Image size 1380x1382. Color fundus photograph: 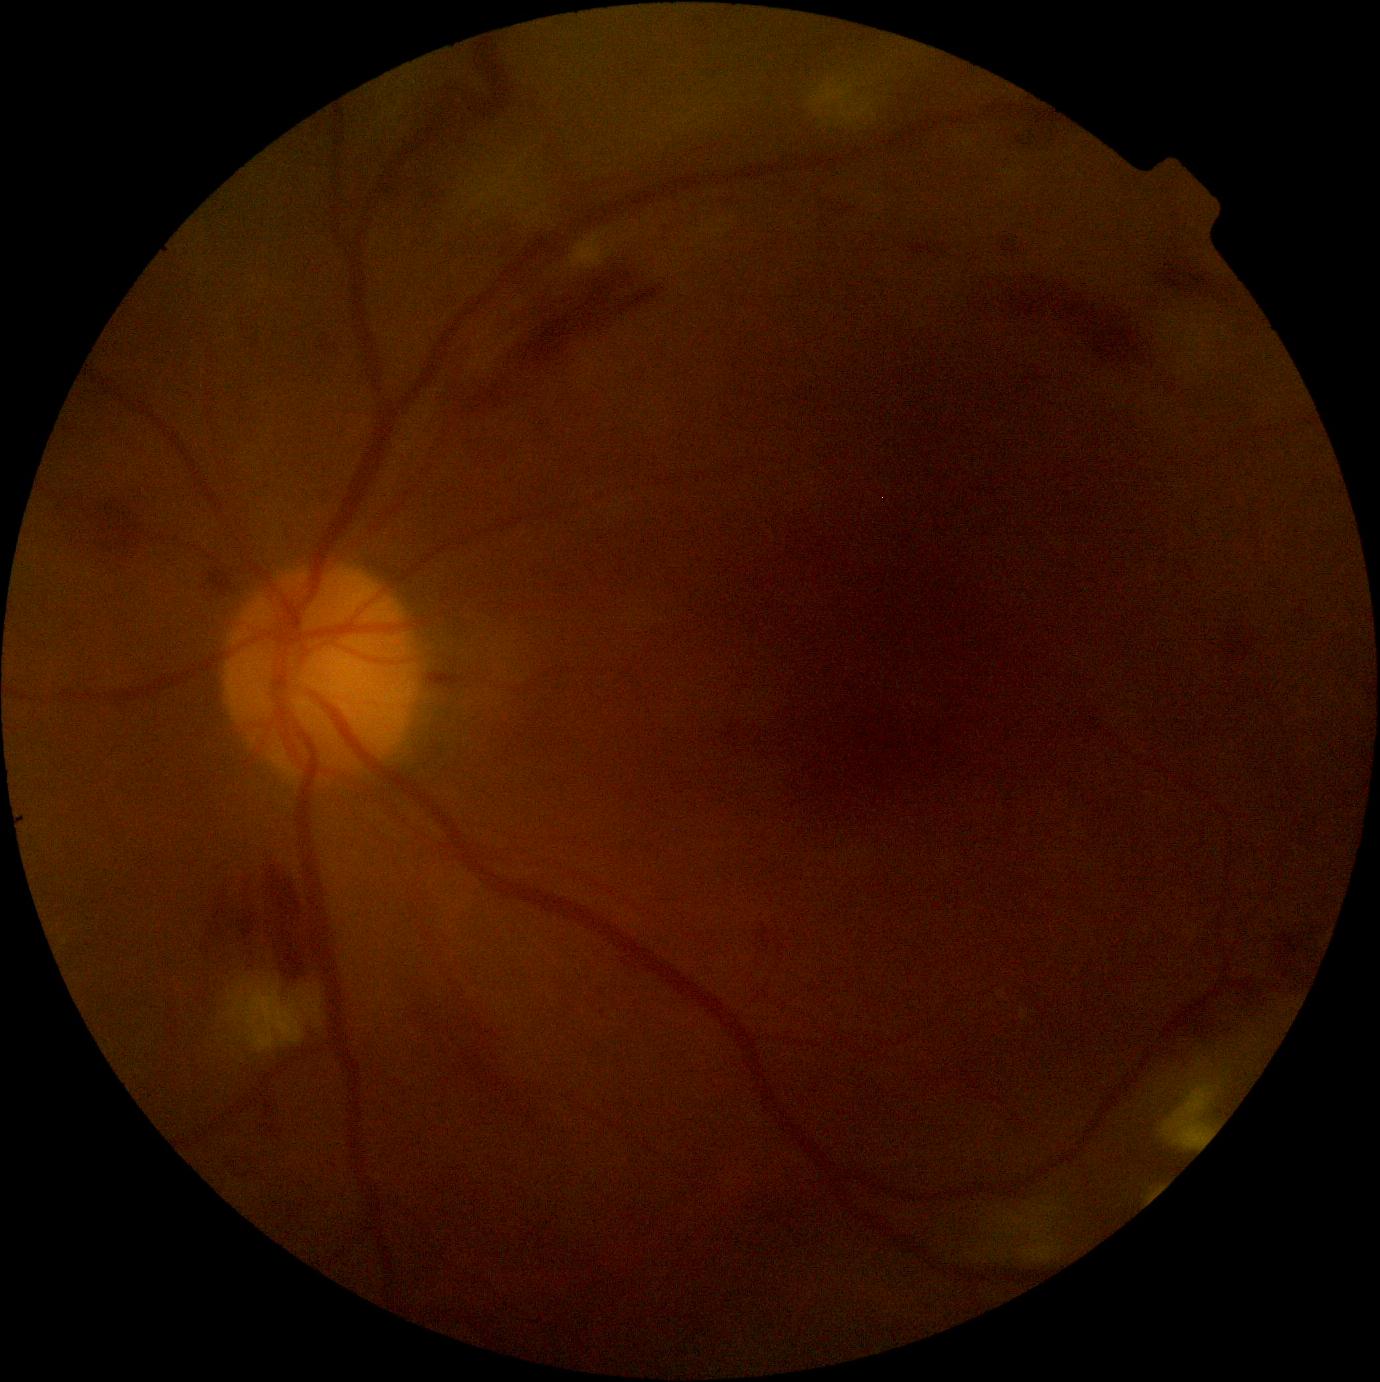

DR = moderate non-proliferative diabetic retinopathy (grade 2) — more than just microaneurysms but less than severe NPDR.